Kowa VX-10α
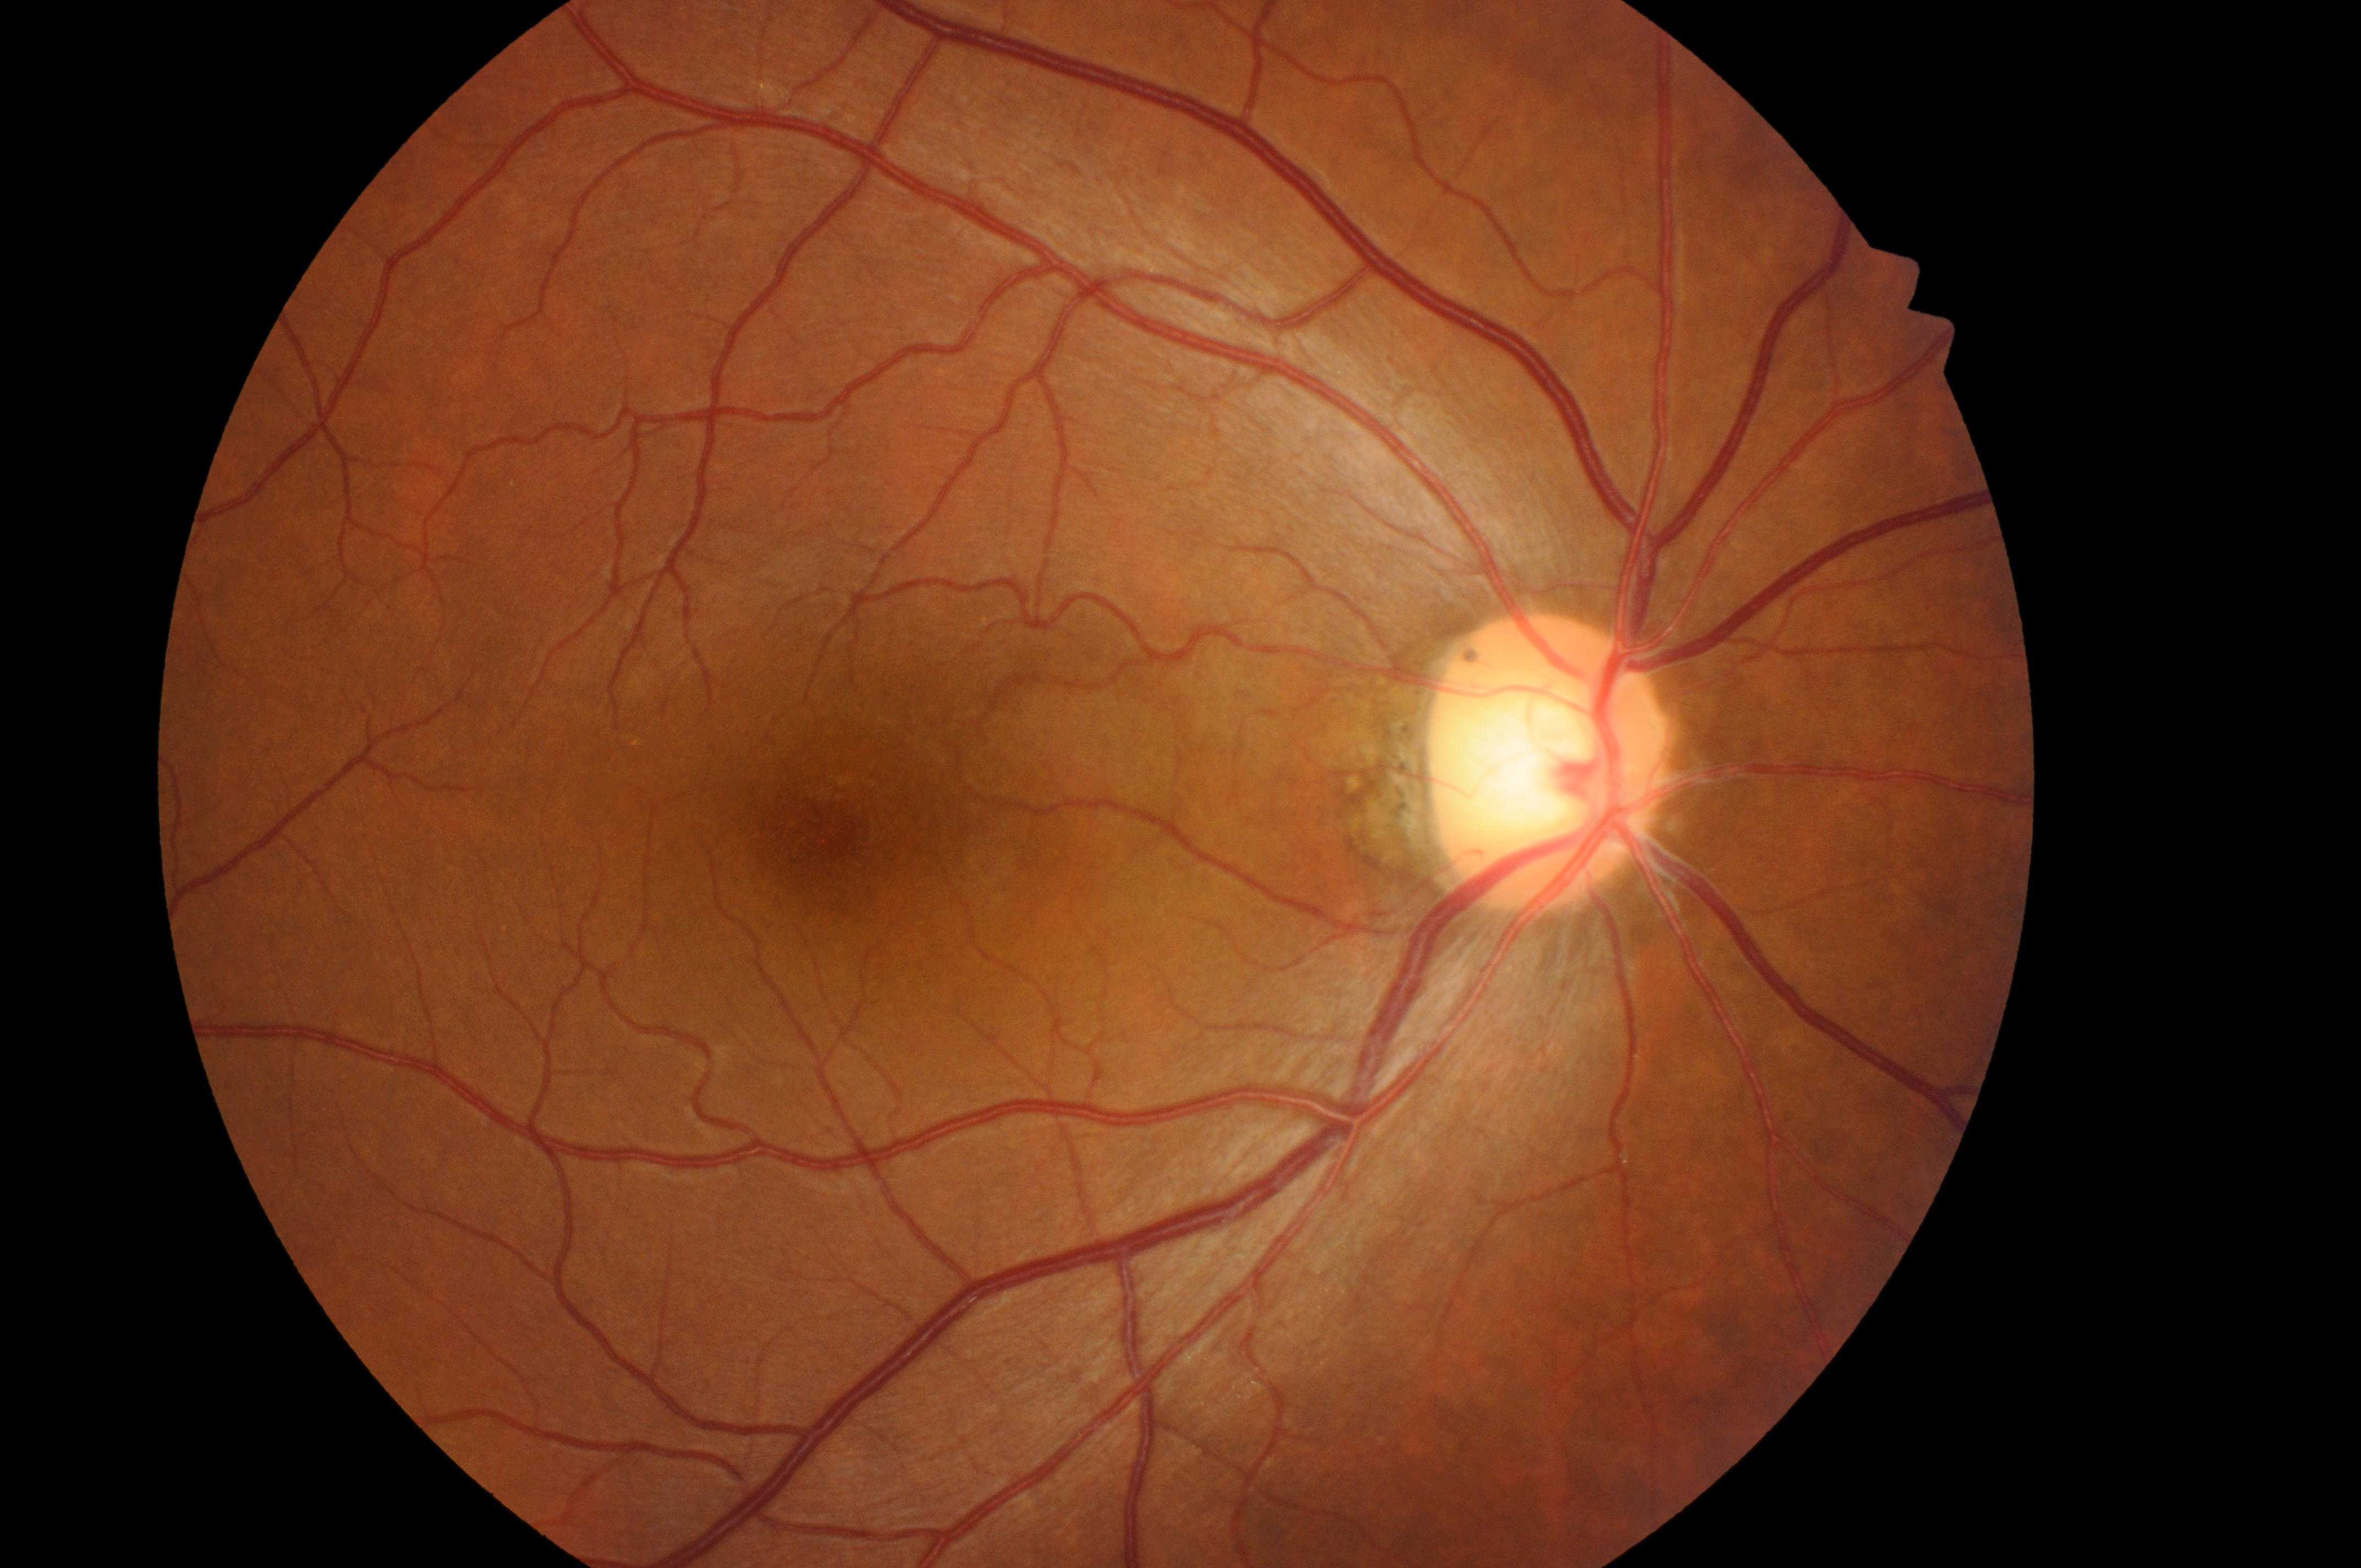
The foveal center is at 835, 831.
Optic disc center: 1545, 773.
Eye: right eye.
DR stage: 0.
DME: 0.